Image size 2212x1659: 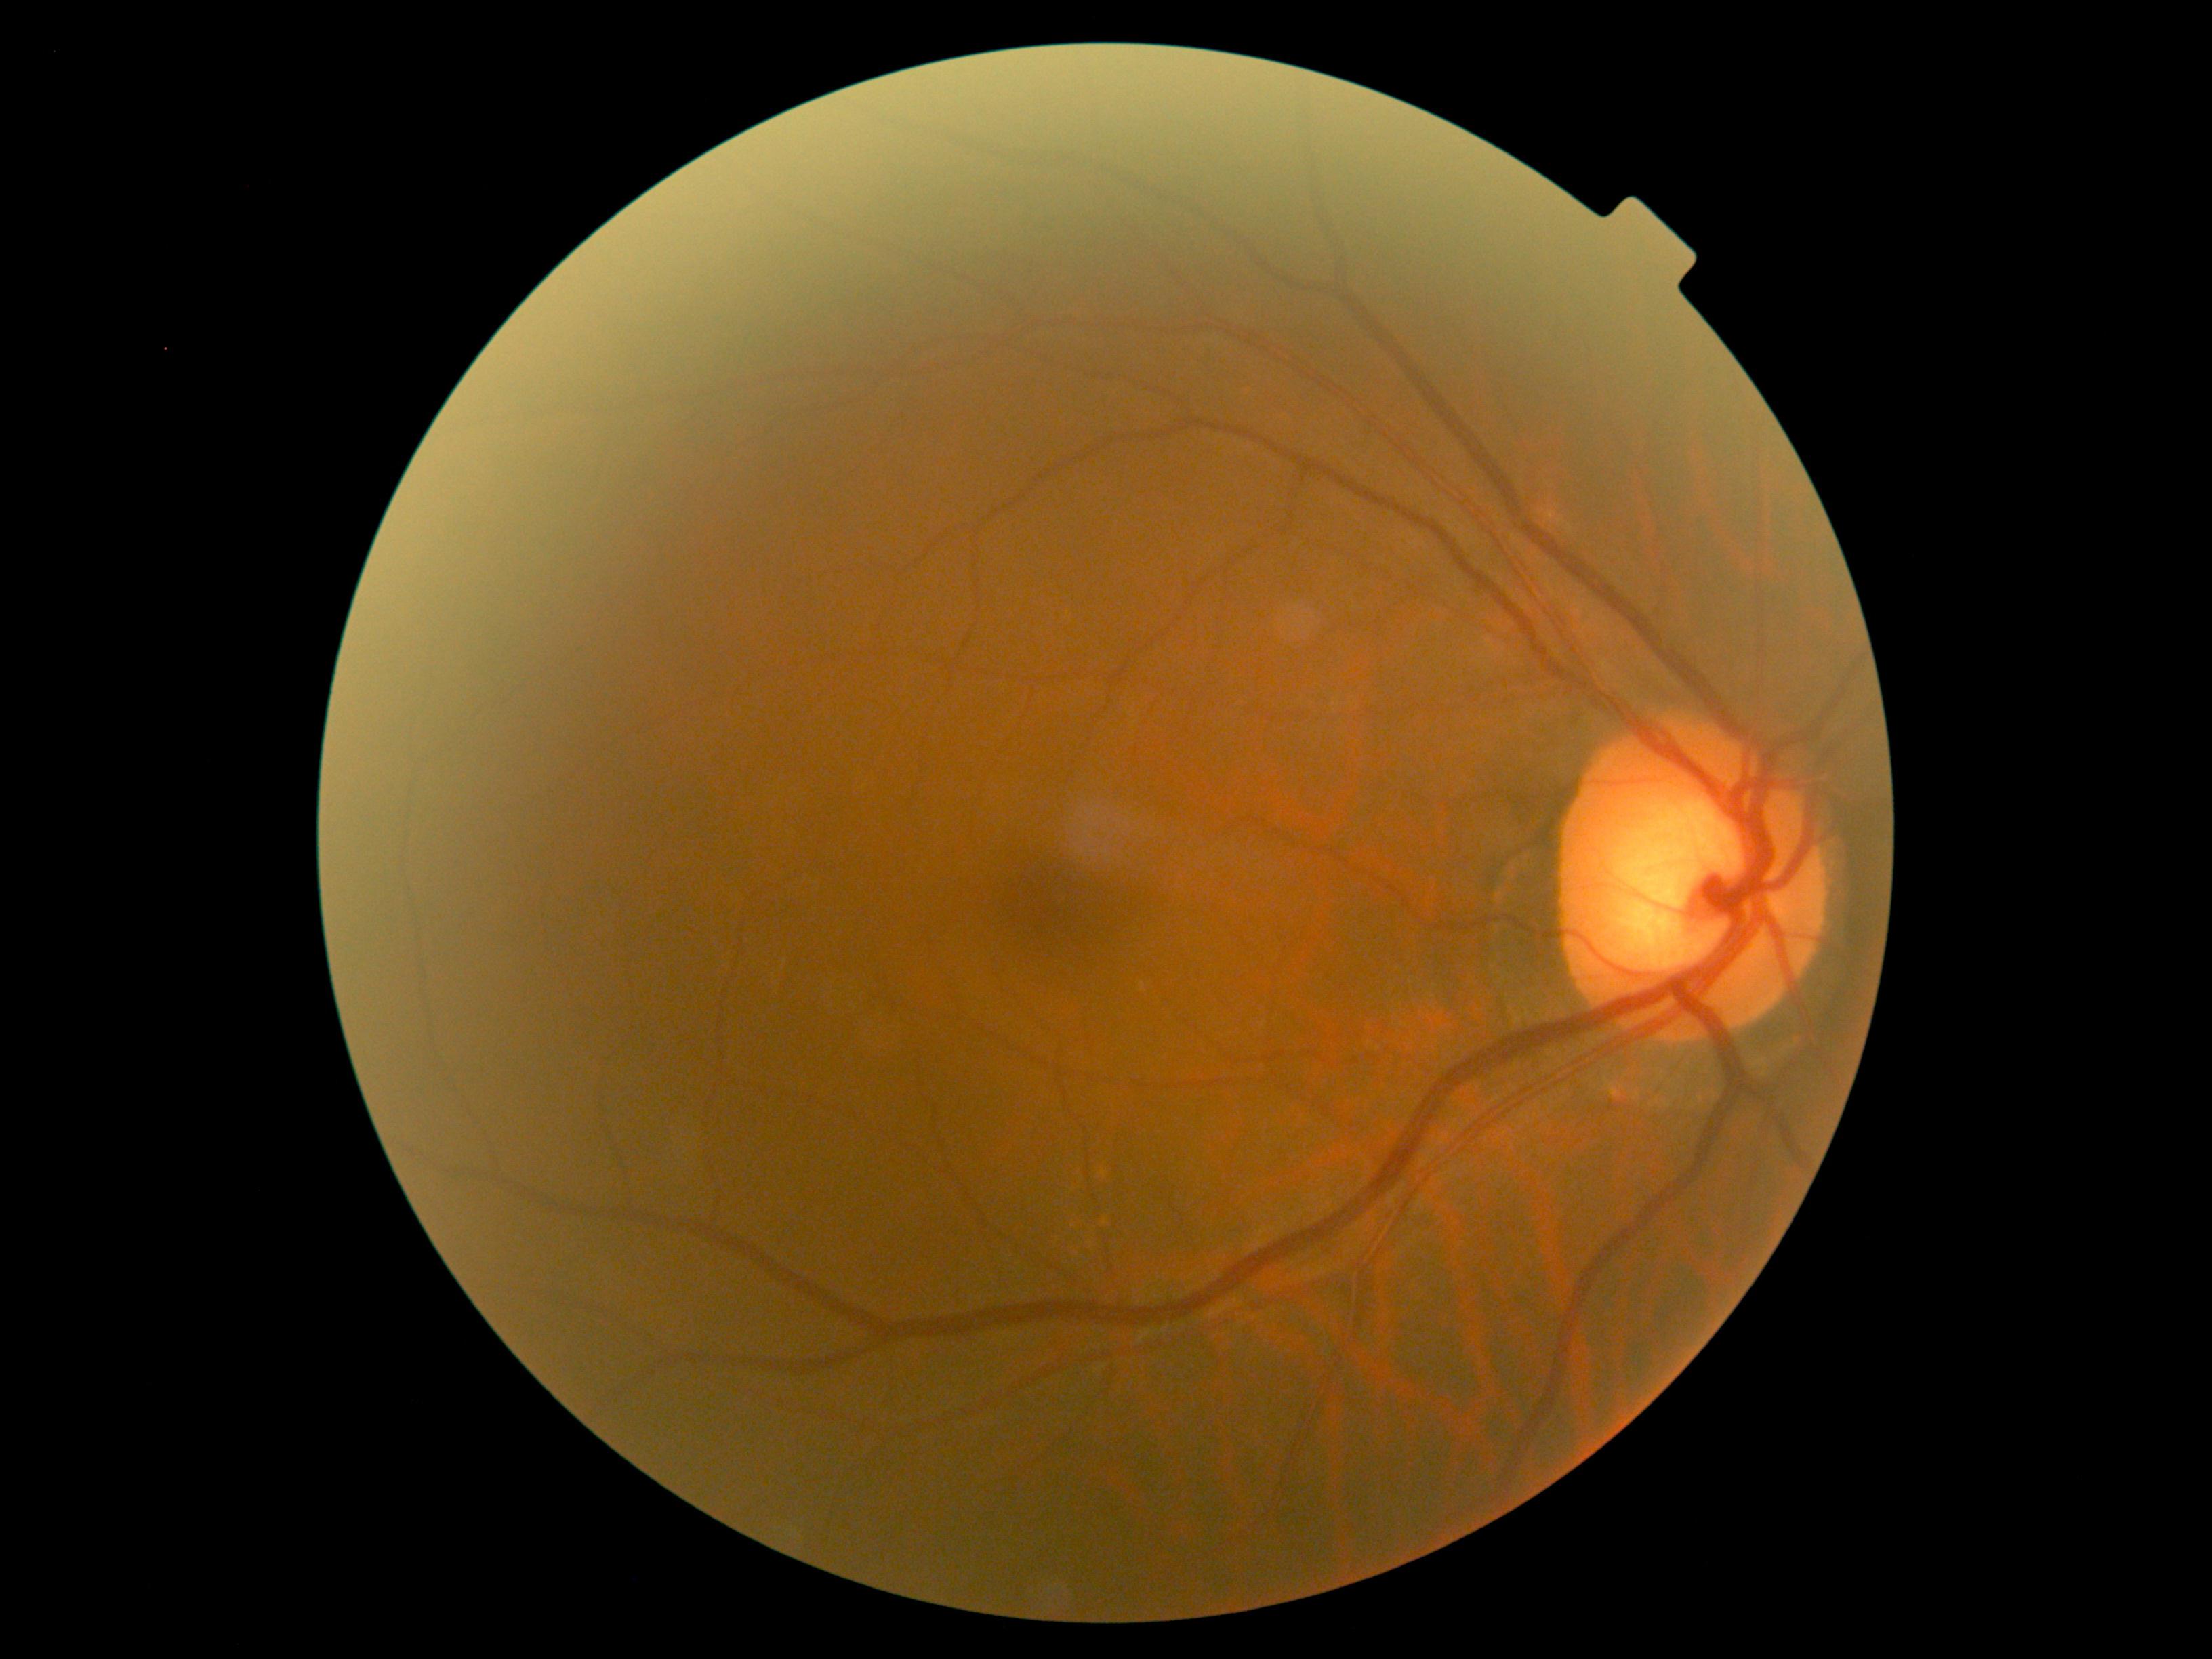

No apparent diabetic retinopathy. Retinopathy is 0/4.